Wide-field fundus photograph of an infant. 1240 by 1240 pixels
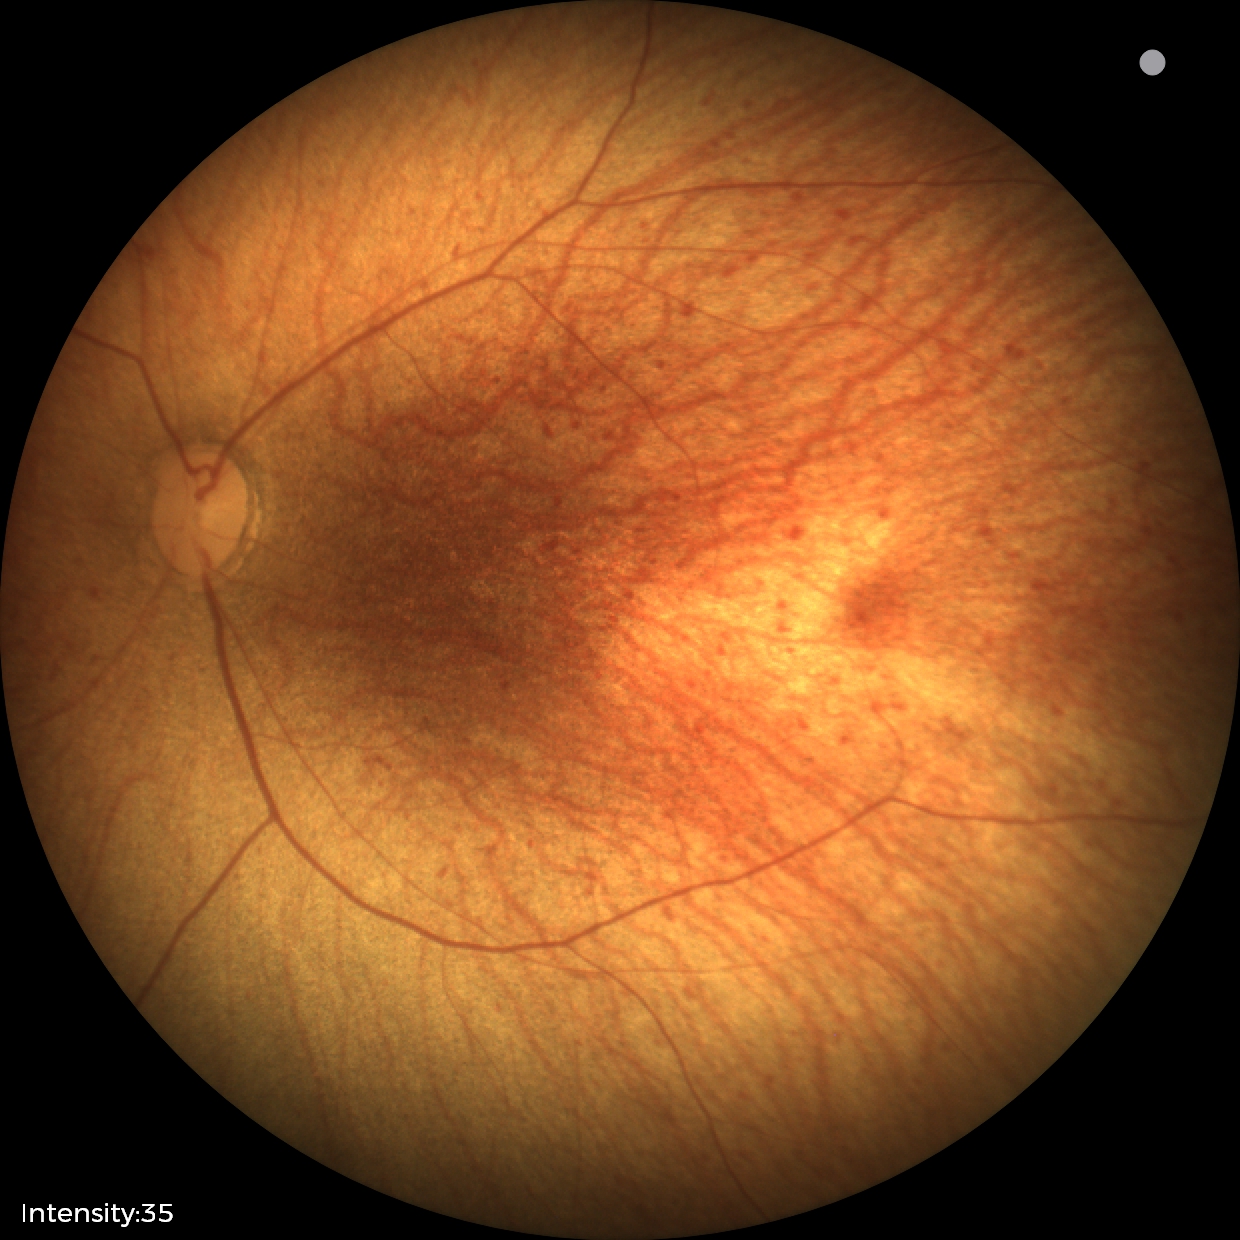 Normal screening examination.